Pediatric wide-field fundus photograph · 1440 by 1080 pixels.
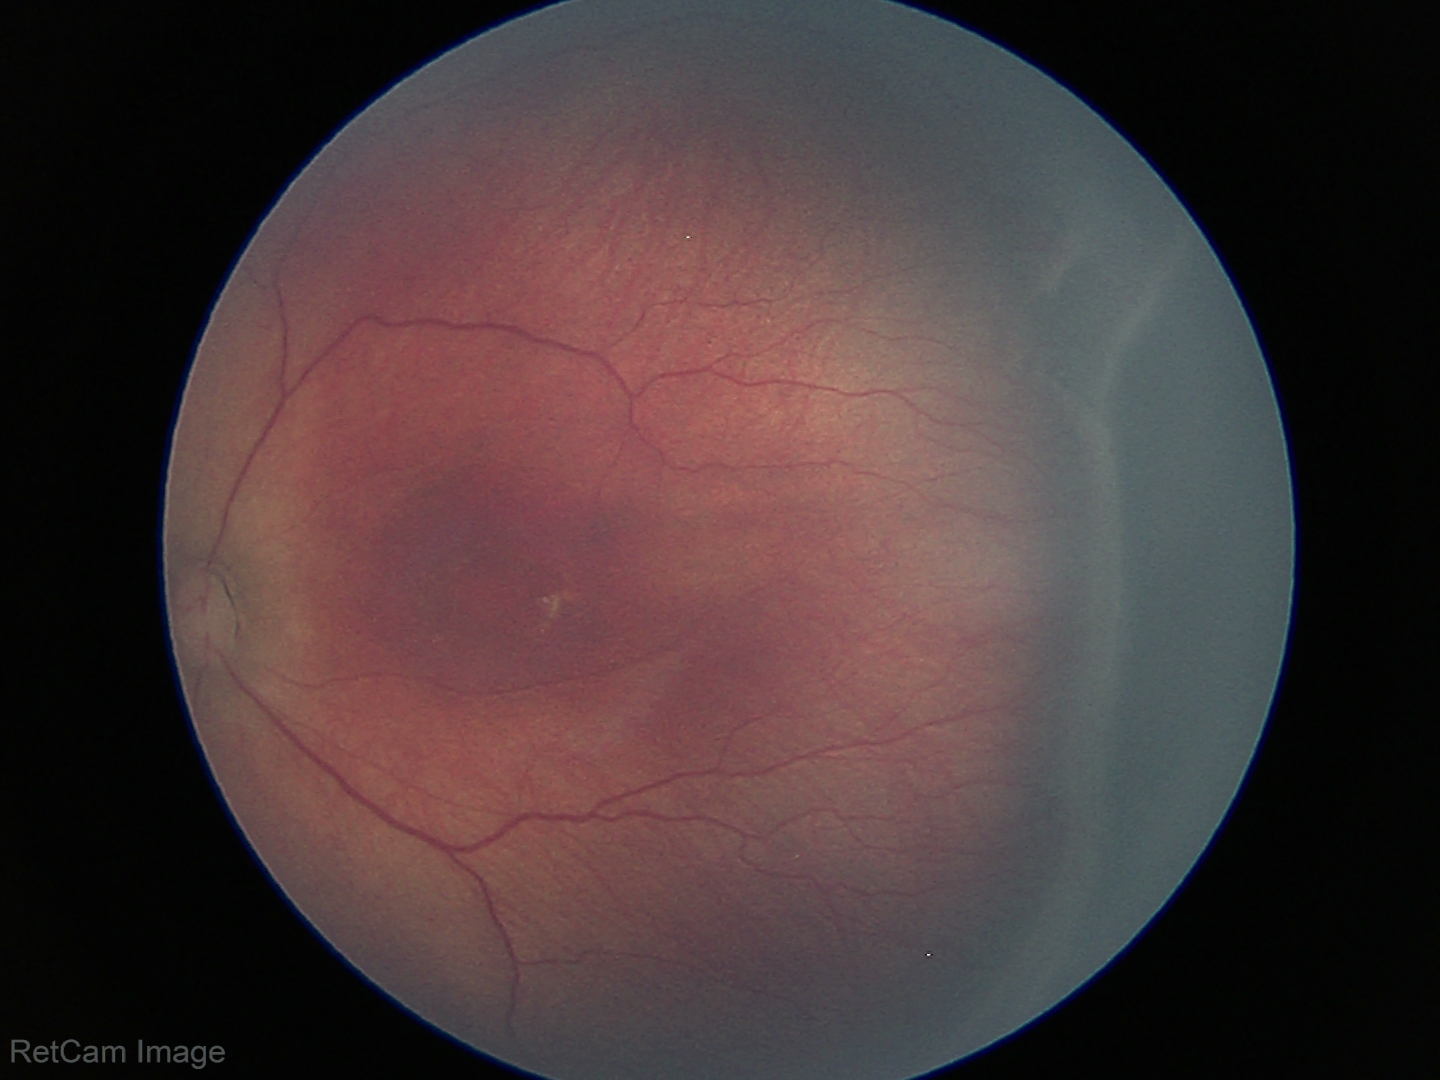

Screening examination consistent with retinopathy of prematurity (ROP) stage 3.